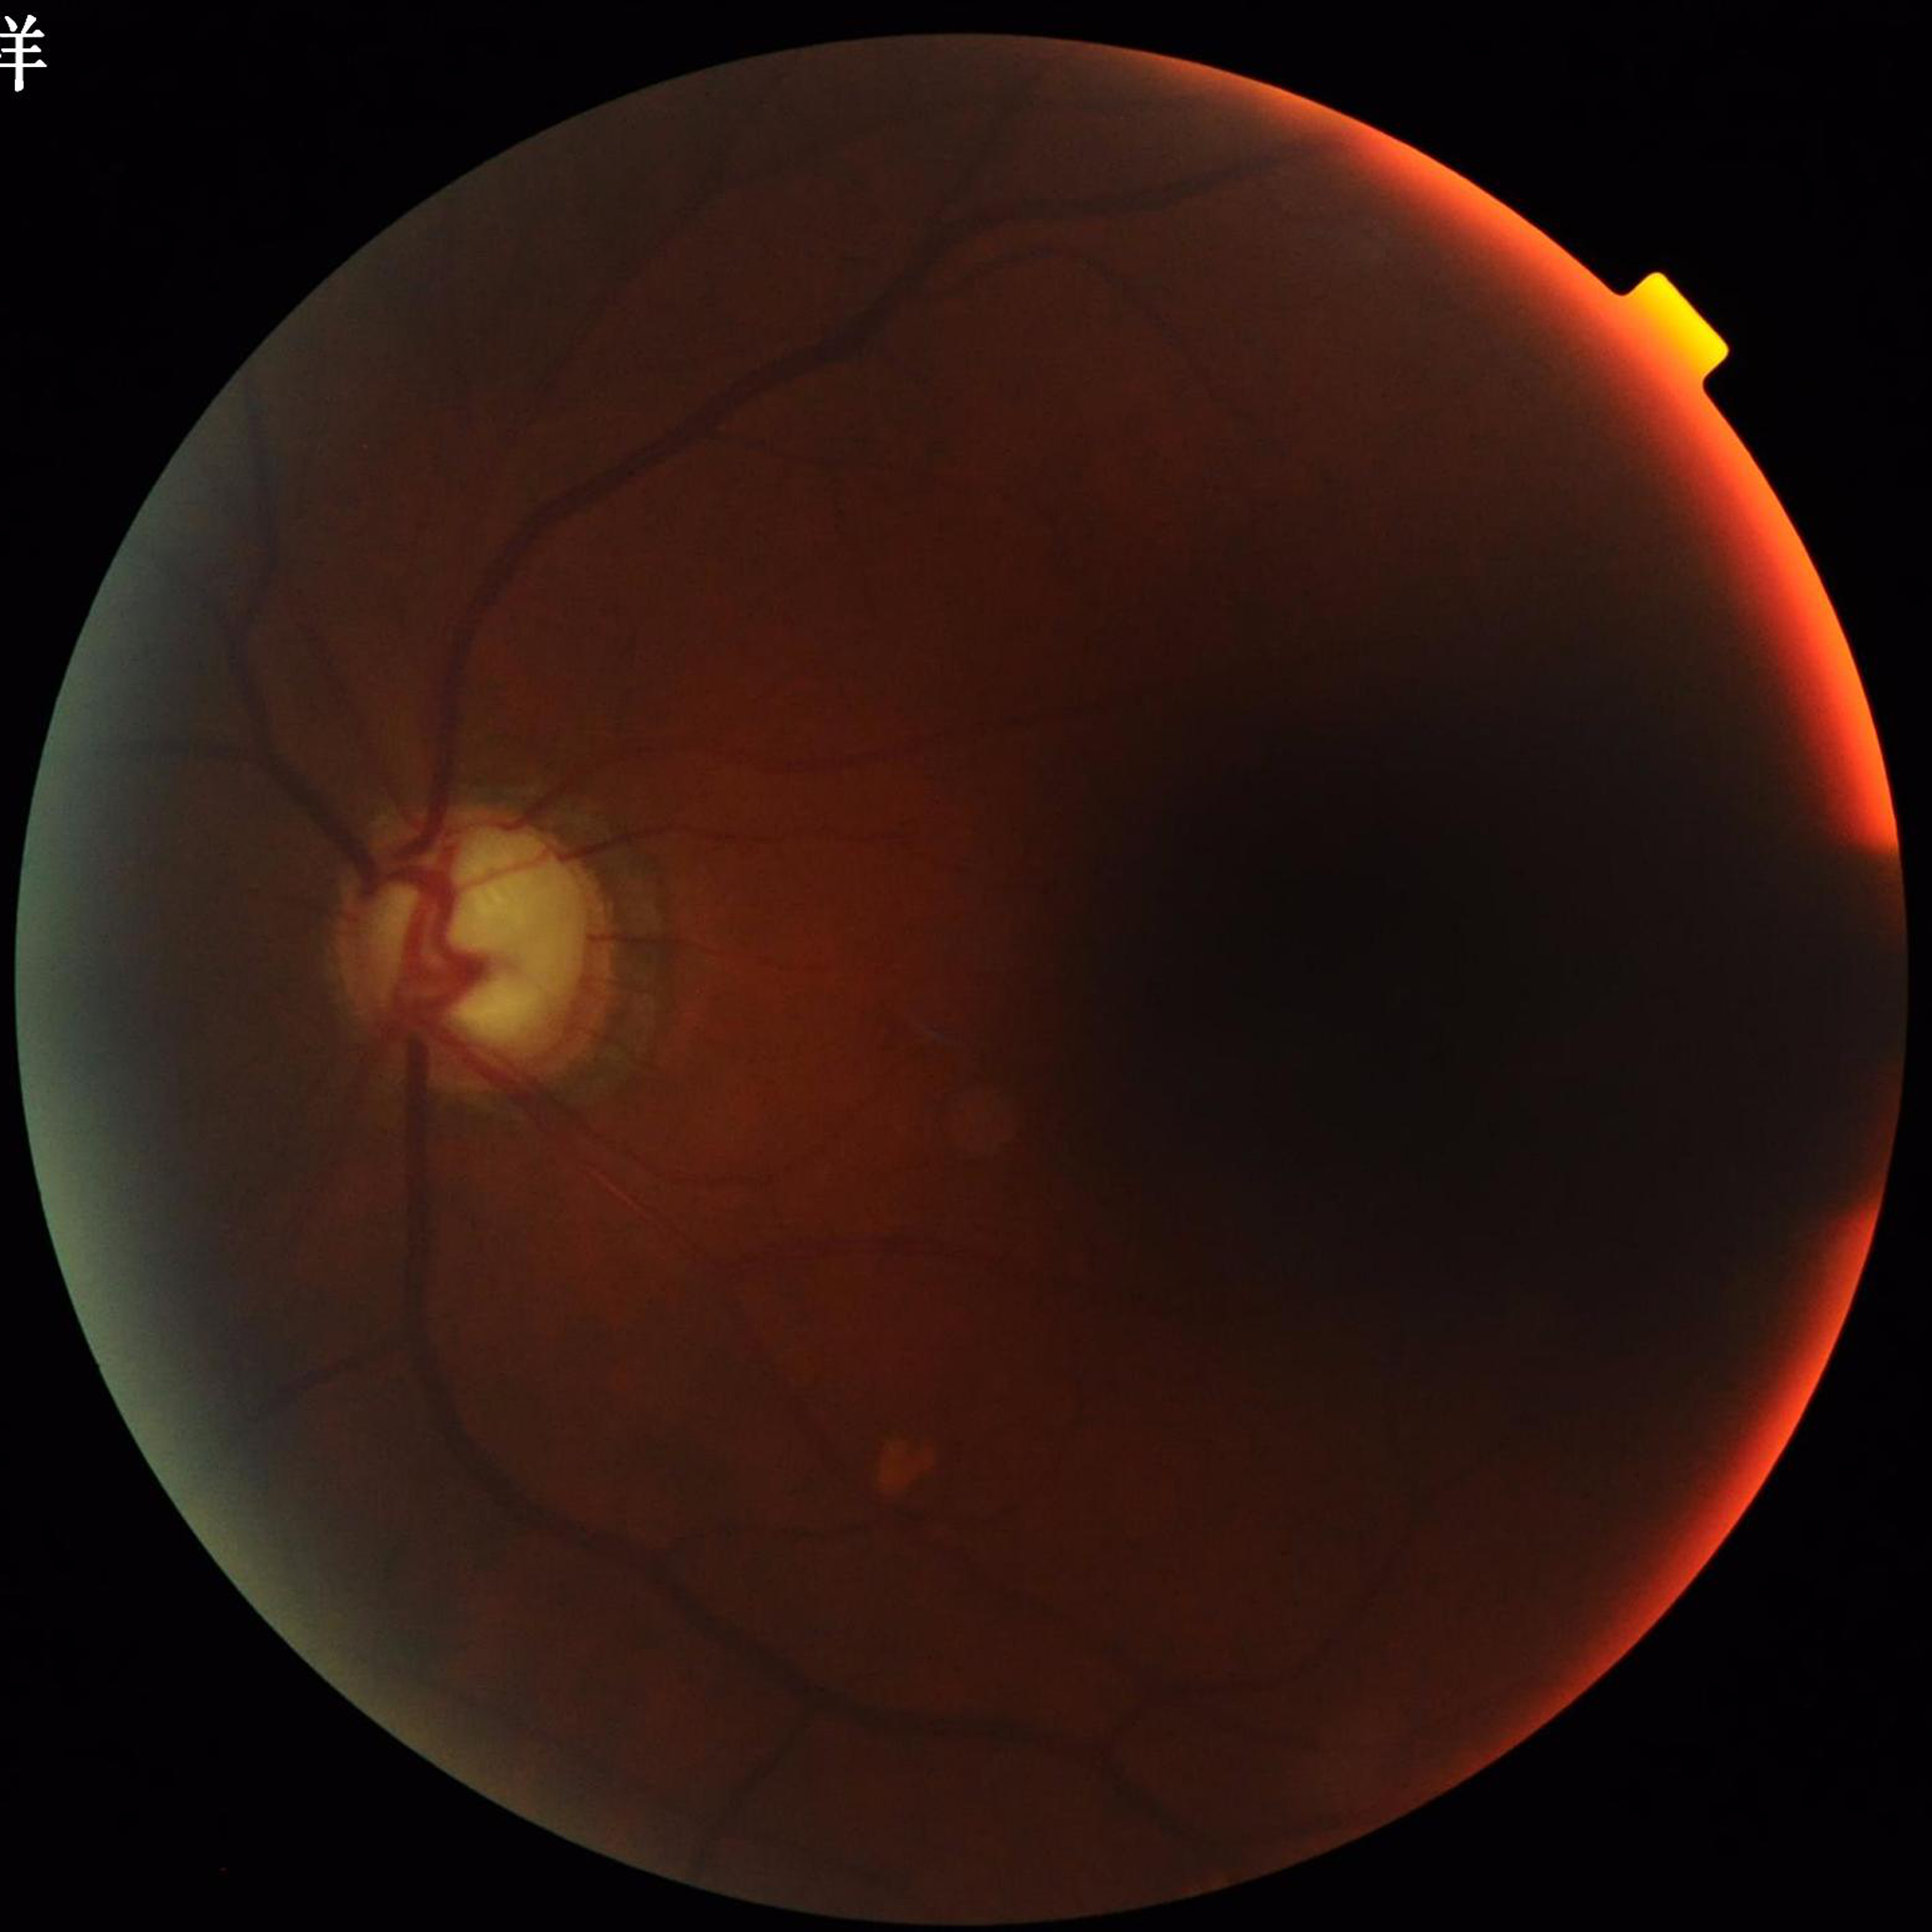

Color fundus photograph from a patient diagnosed with glaucoma. Image quality: poor — illumination/color distortion, blur.